Optic disc-centered crop:
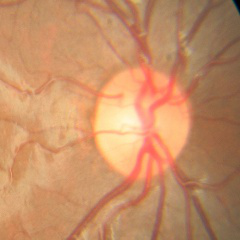
Diagnosis: no glaucomatous findings.